FOV: 45 degrees, graded on the modified Davis scale.
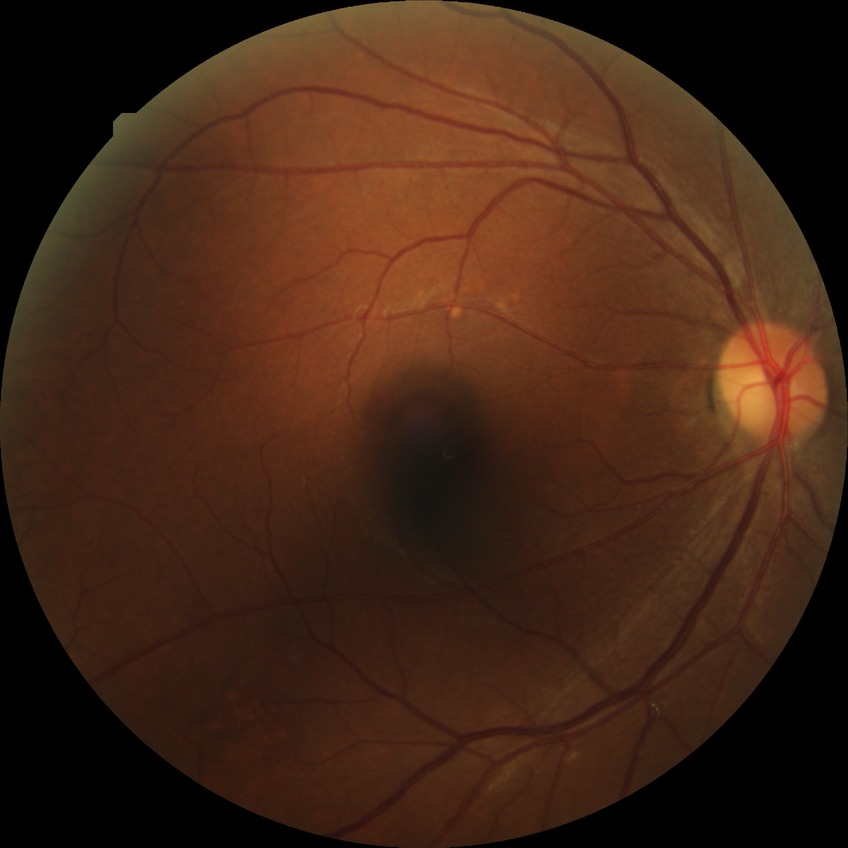
Diabetic retinopathy grade is no diabetic retinopathy.